Color fundus image, 2048x1536px: 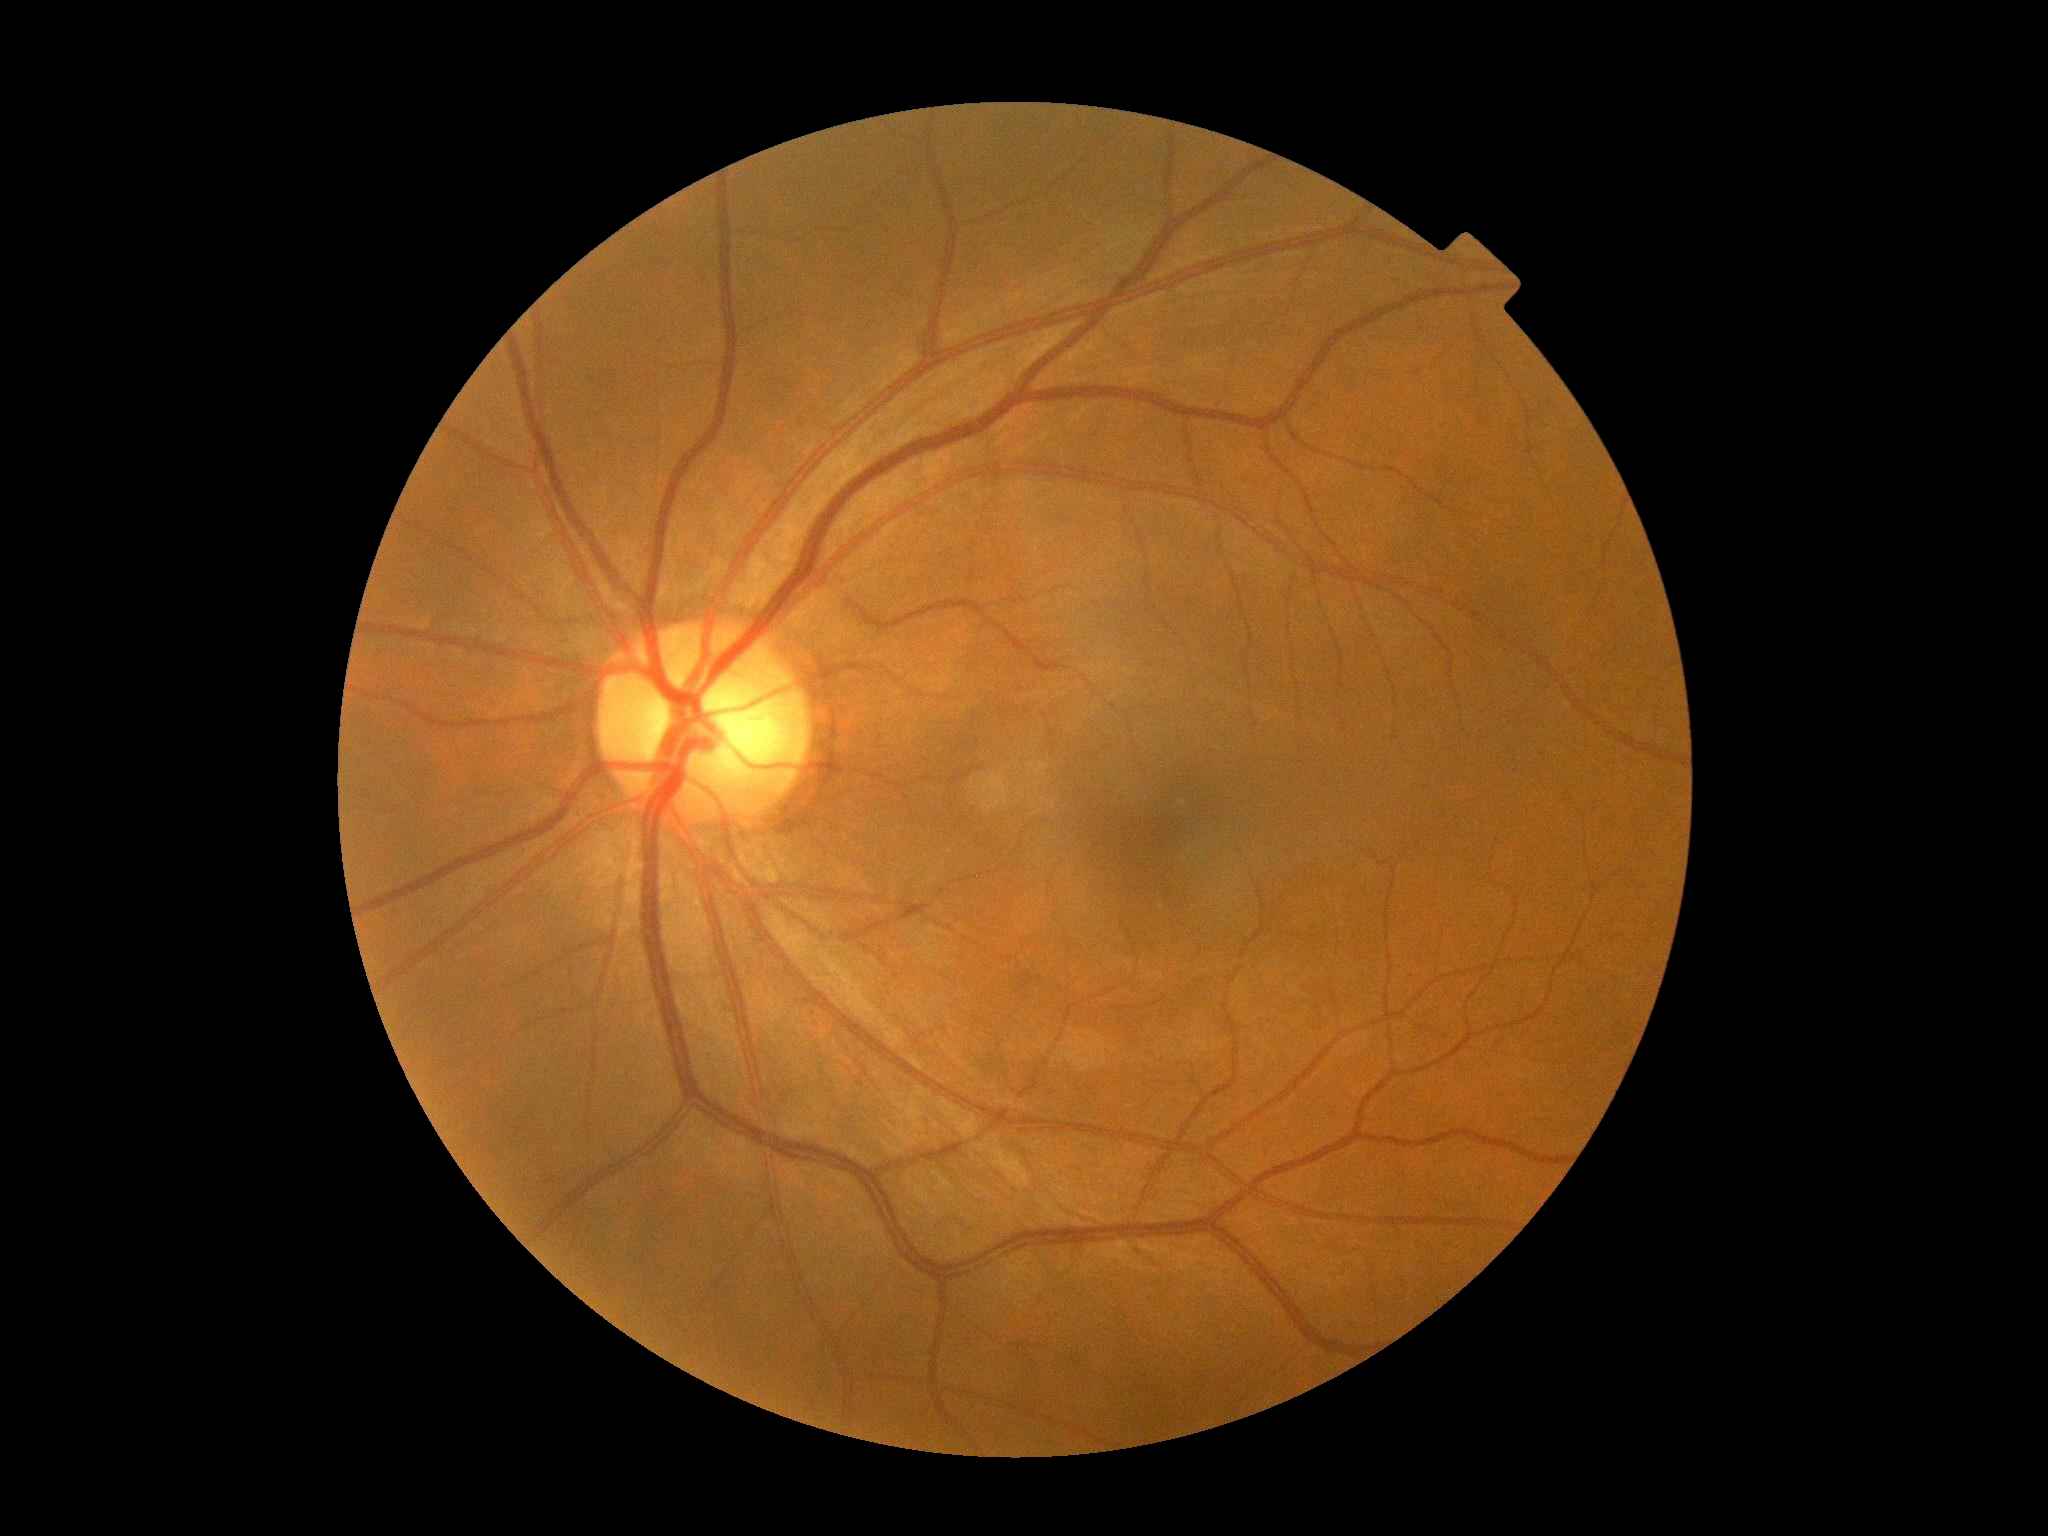
Findings:
• DR impression: no apparent DR
• DR severity: grade 0 (no apparent retinopathy)